Captured after pupil dilation. Posterior pole field covering the optic disc and macula. Image size 2228x1652. Captured on a Topcon TRC-50DX fundus camera. FOV: 50 degrees. Retinal fundus photograph — 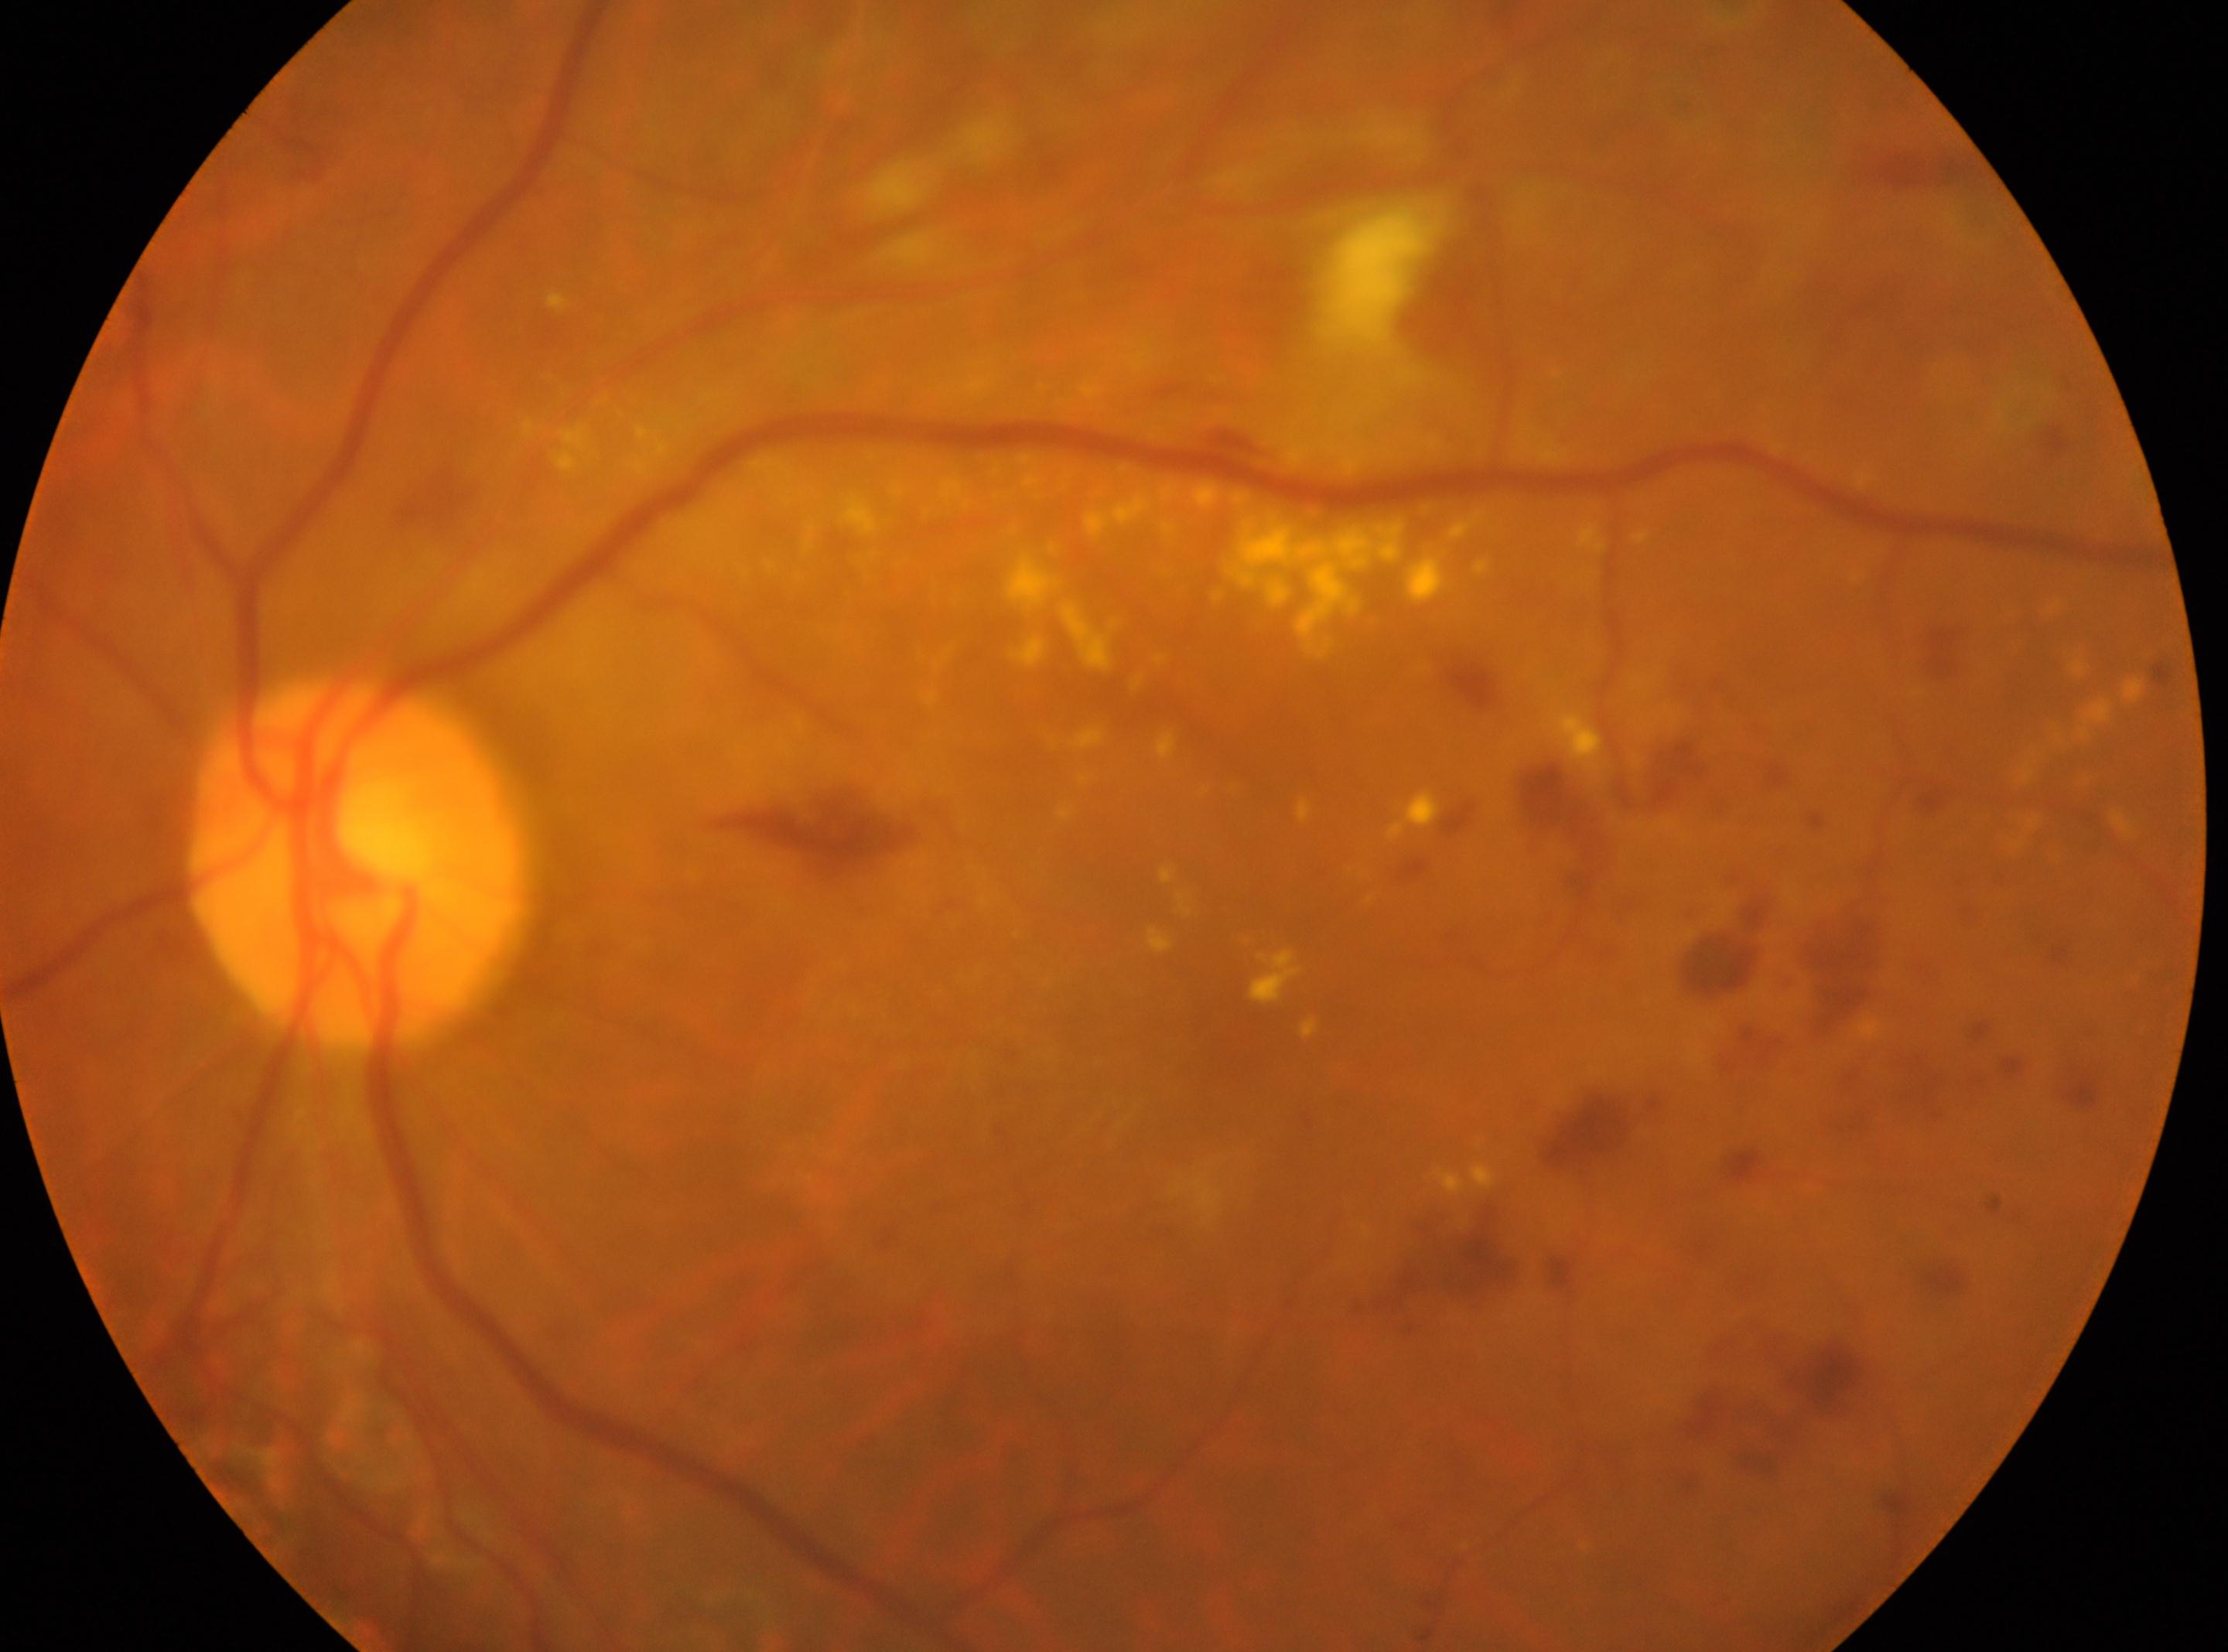

DR severity: 2. Optic disk: (356, 864). Foveal center: (1238, 1030). This is the OS.